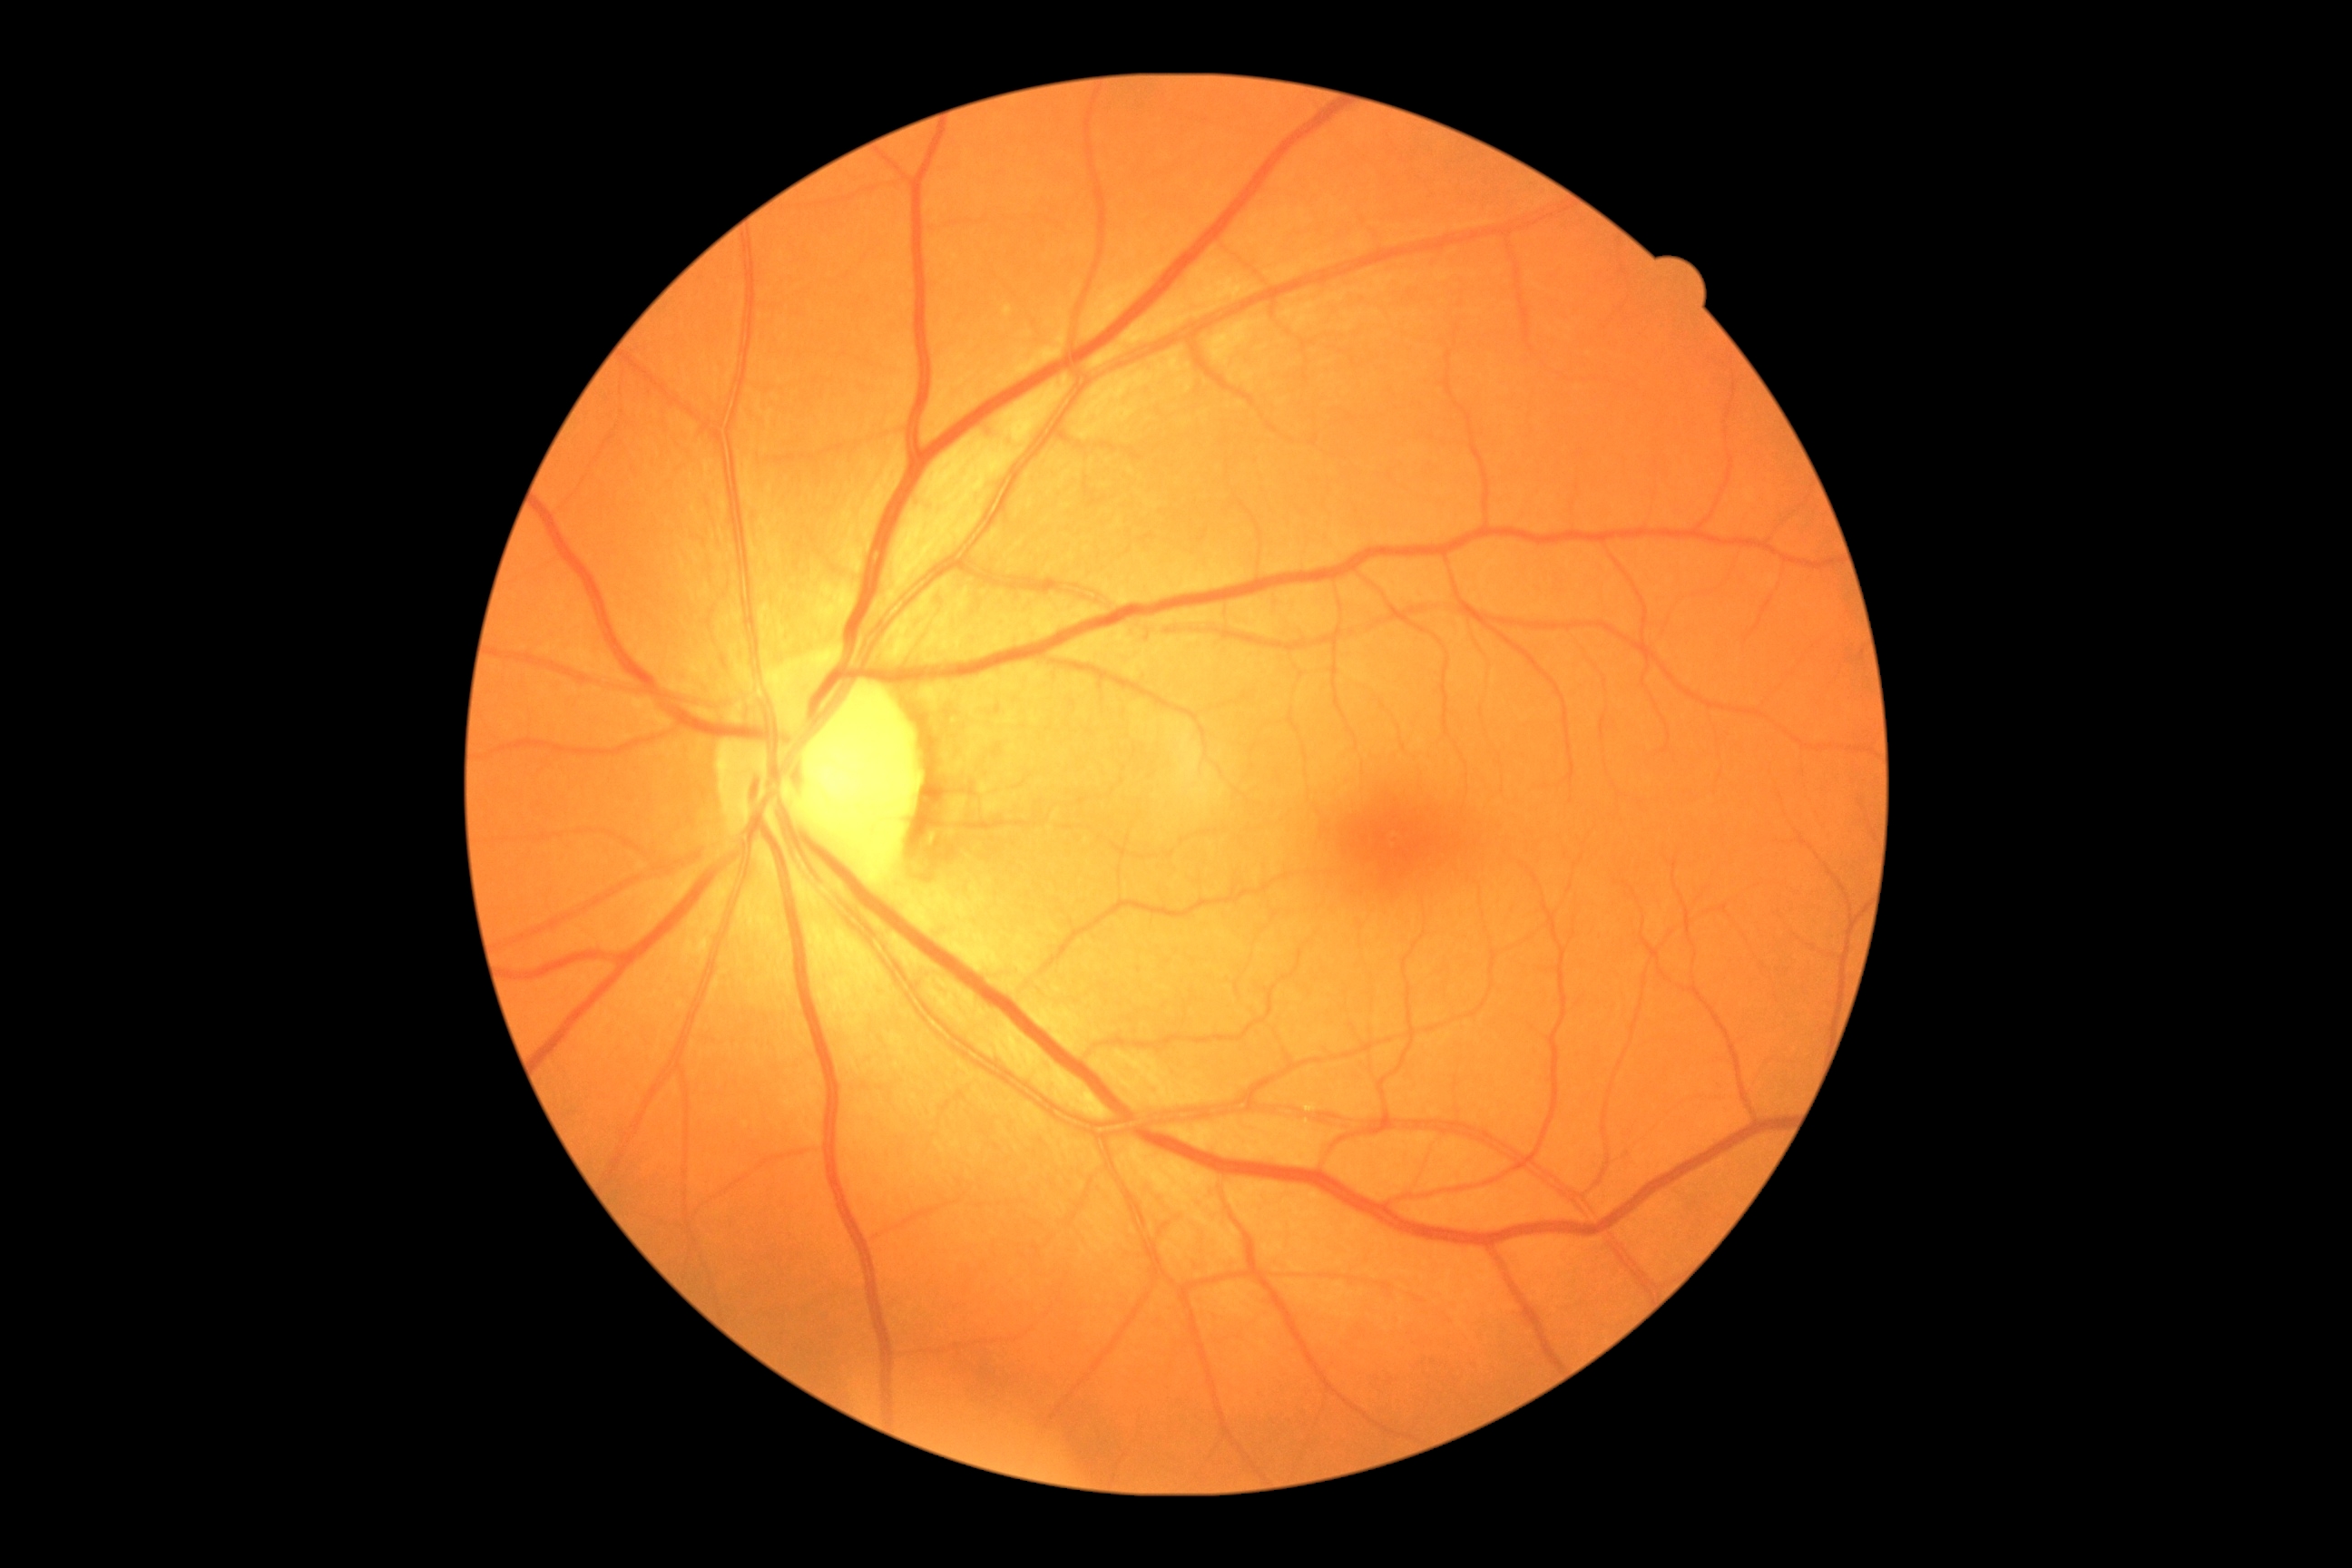
Annotations:
* DR impression — no signs of DR
* diabetic retinopathy severity — no apparent retinopathy (grade 0)